Modified Davis grading, NIDEK AFC-230 fundus camera, color fundus photograph:
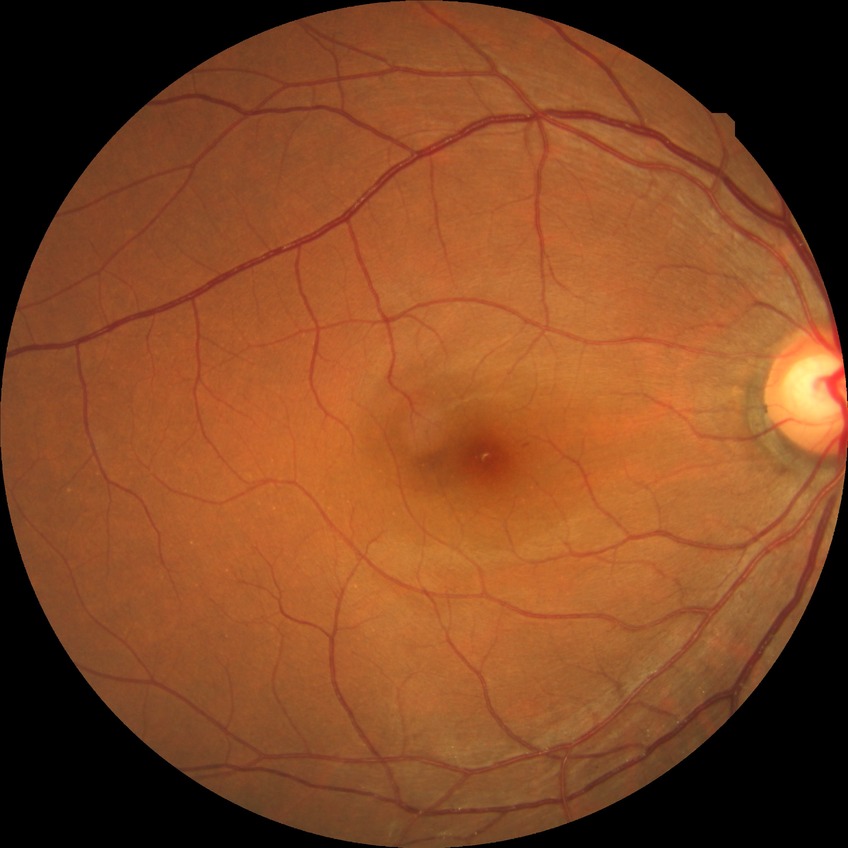

Diabetic retinopathy (DR) is SDR (simple diabetic retinopathy).